45° field of view · diabetic retinopathy graded by the modified Davis classification.
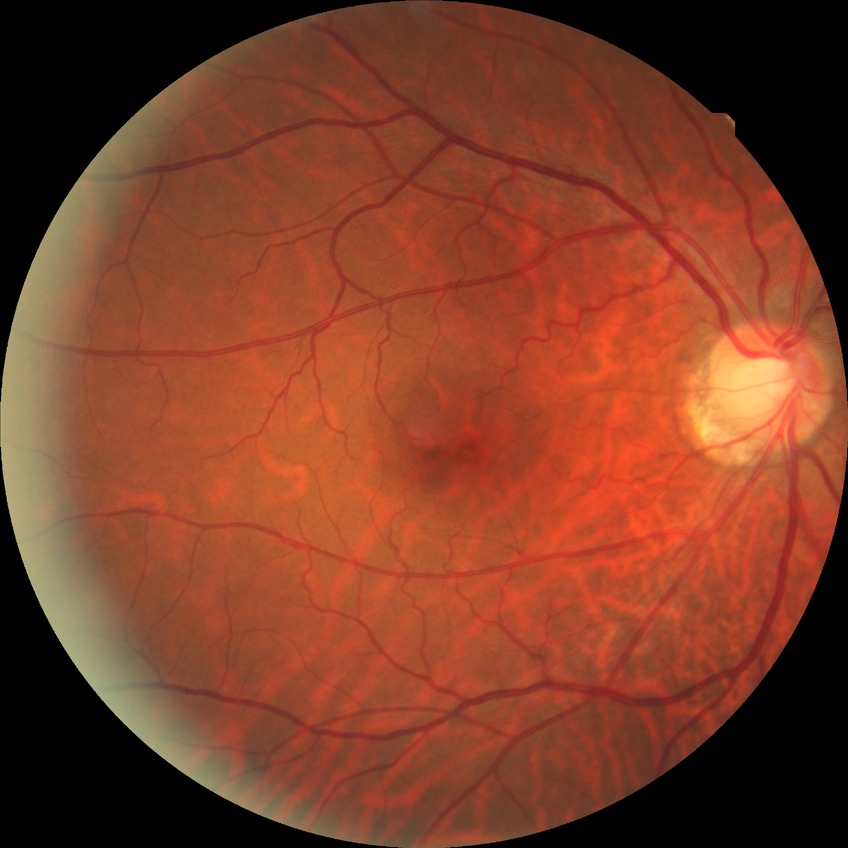

Assessment:
• diabetic retinopathy (DR): no diabetic retinopathy (NDR)